Image size 240x240. Camera: Nidek AFC-330. Color fundus image:
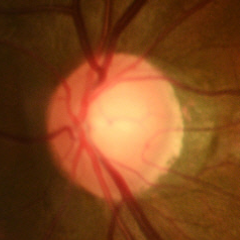 Q: Does this eye have glaucoma?
A: Yes — early-stage glaucoma. Diagnostic criteria: glaucomatous retinal nerve fiber layer defects on red-free fundus photography without visual field defects.